Ultra-widefield (UWF) fundus image. 200° field of view. 1924x1556px — 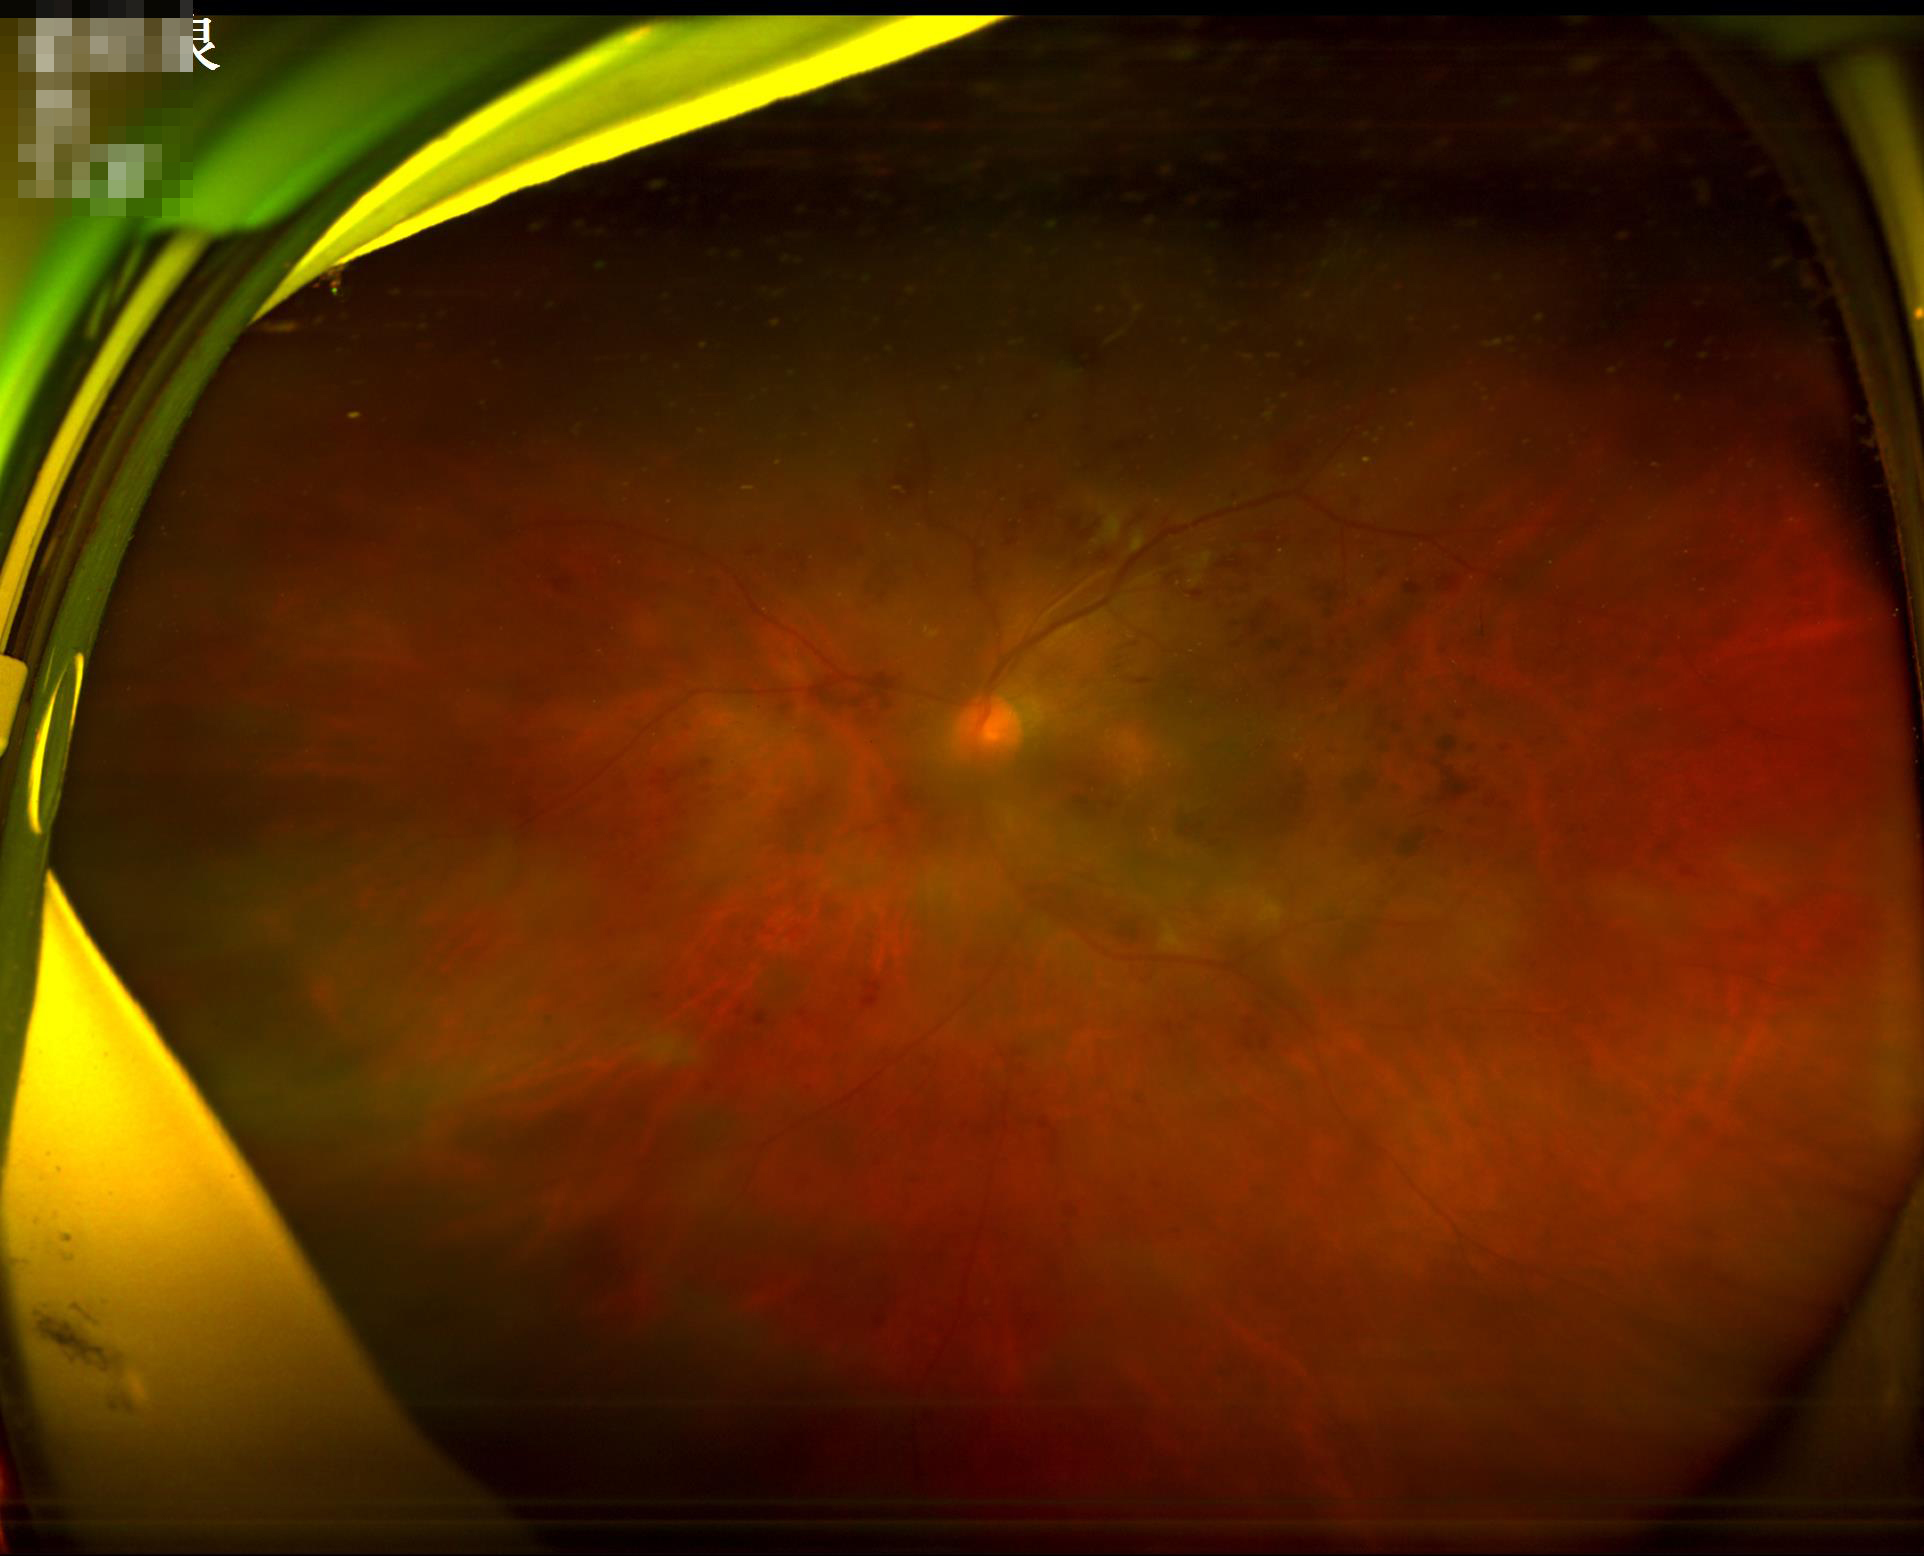
Out of focus; structures are indistinct.
Poor illumination with uneven exposure.
Overall image quality is poor.
Poor dynamic range.